NIDEK AFC-230 · 45° field of view · modified Davis grading:
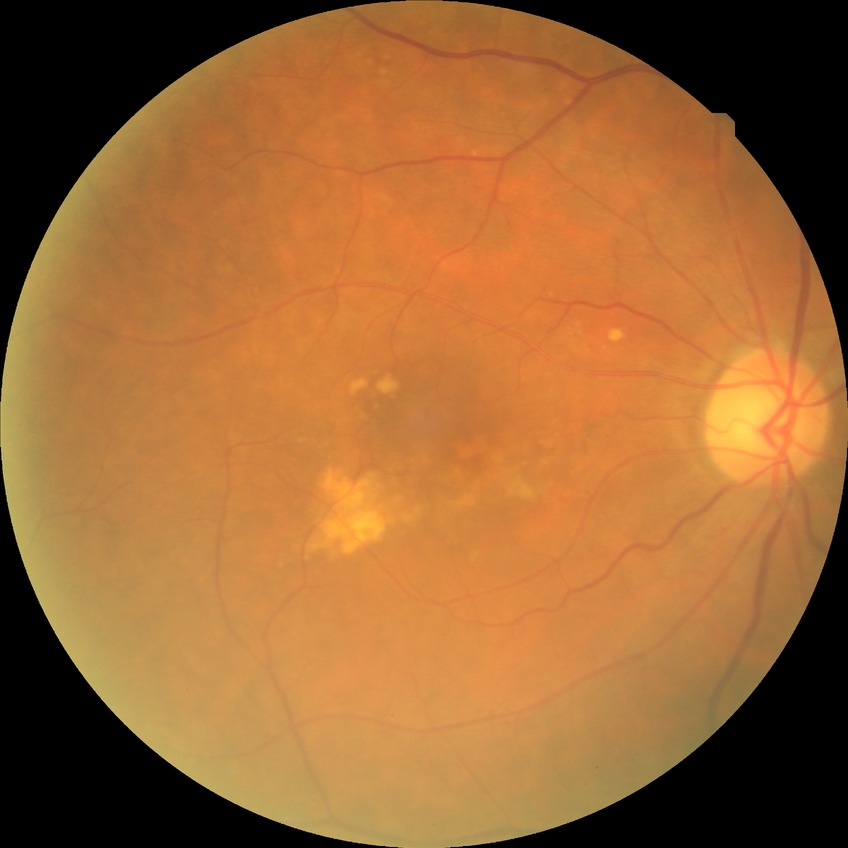
diabetic retinopathy (DR): no diabetic retinopathy (NDR).